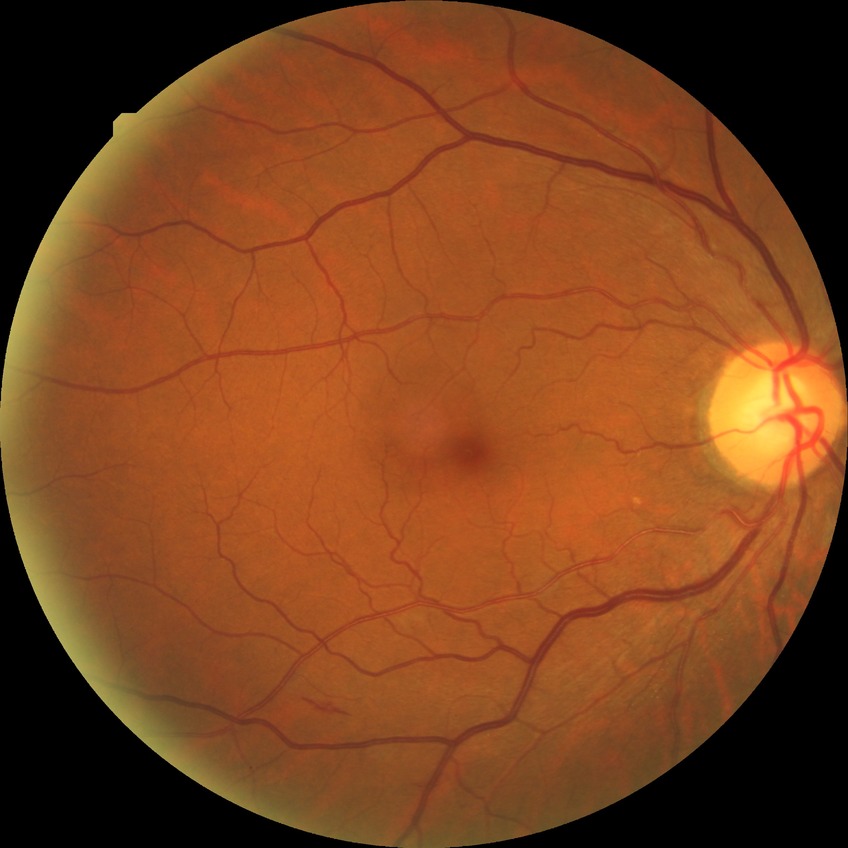

Findings:
• diabetic retinopathy (DR): simple diabetic retinopathy (SDR)
• DR class: non-proliferative diabetic retinopathy